FOV: 45 degrees.
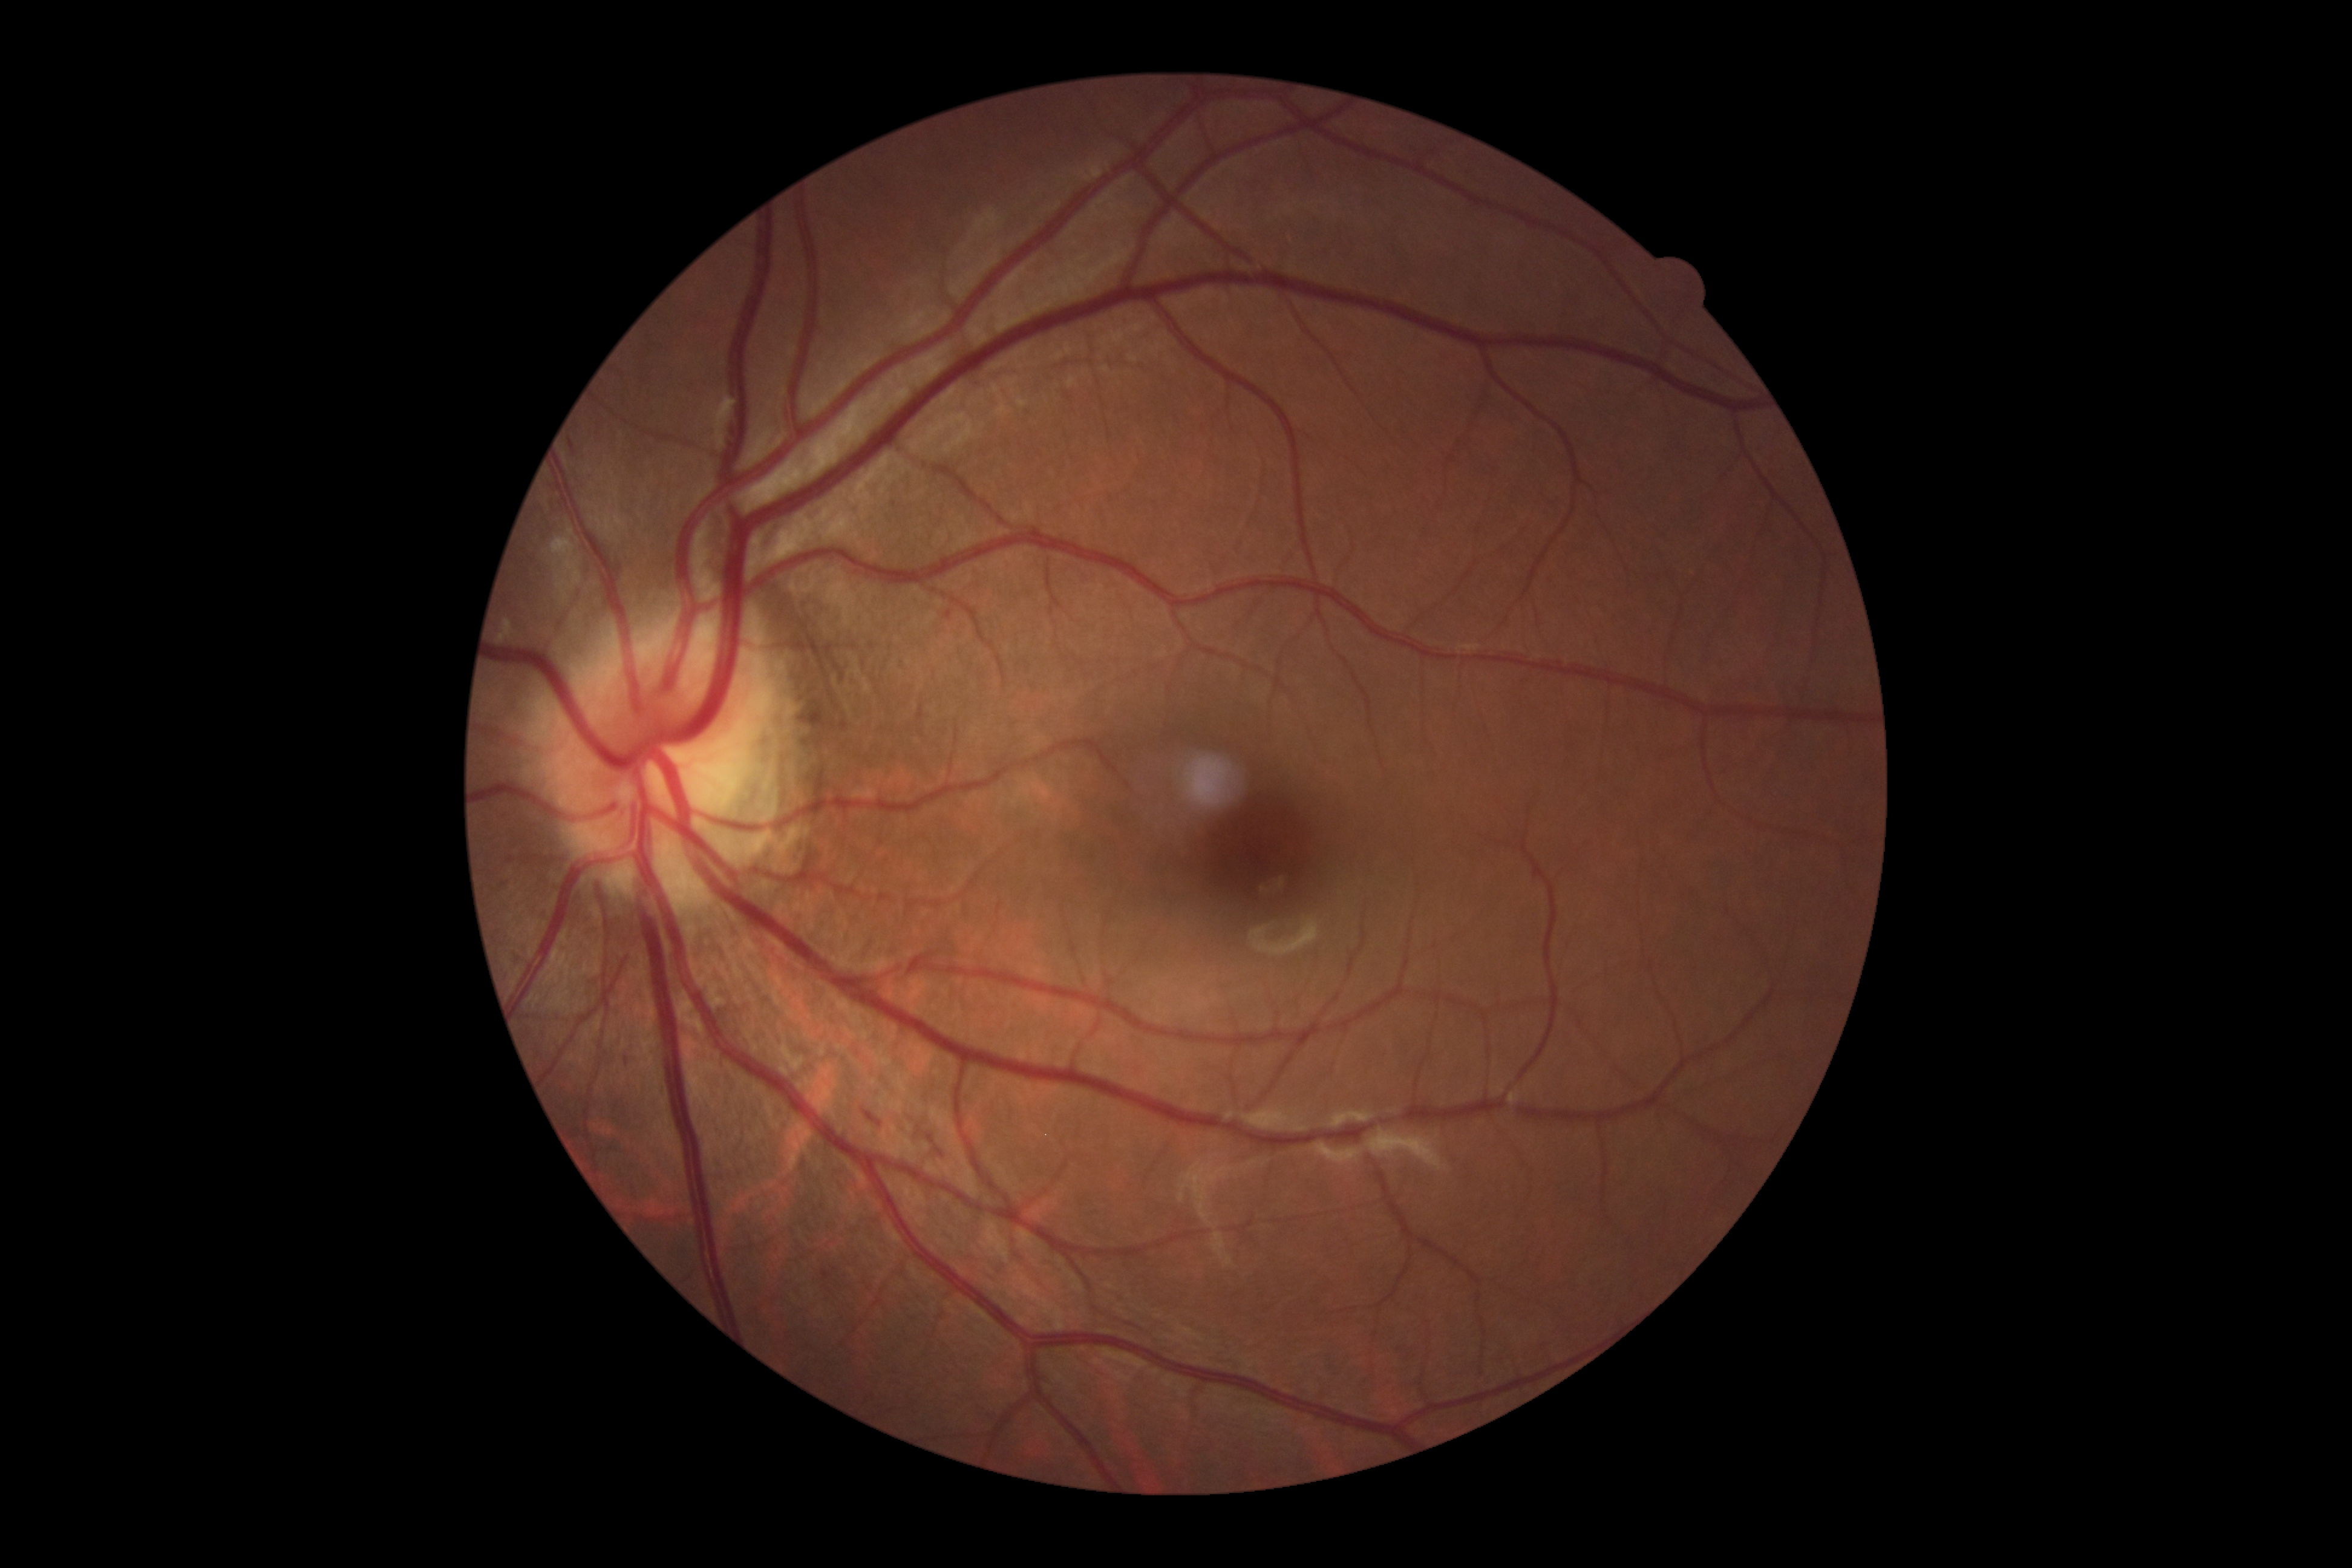 Diabetic retinopathy (DR) is 2/4.